Camera: Phoenix ICON (100° FOV); wide-field fundus photograph from neonatal ROP screening
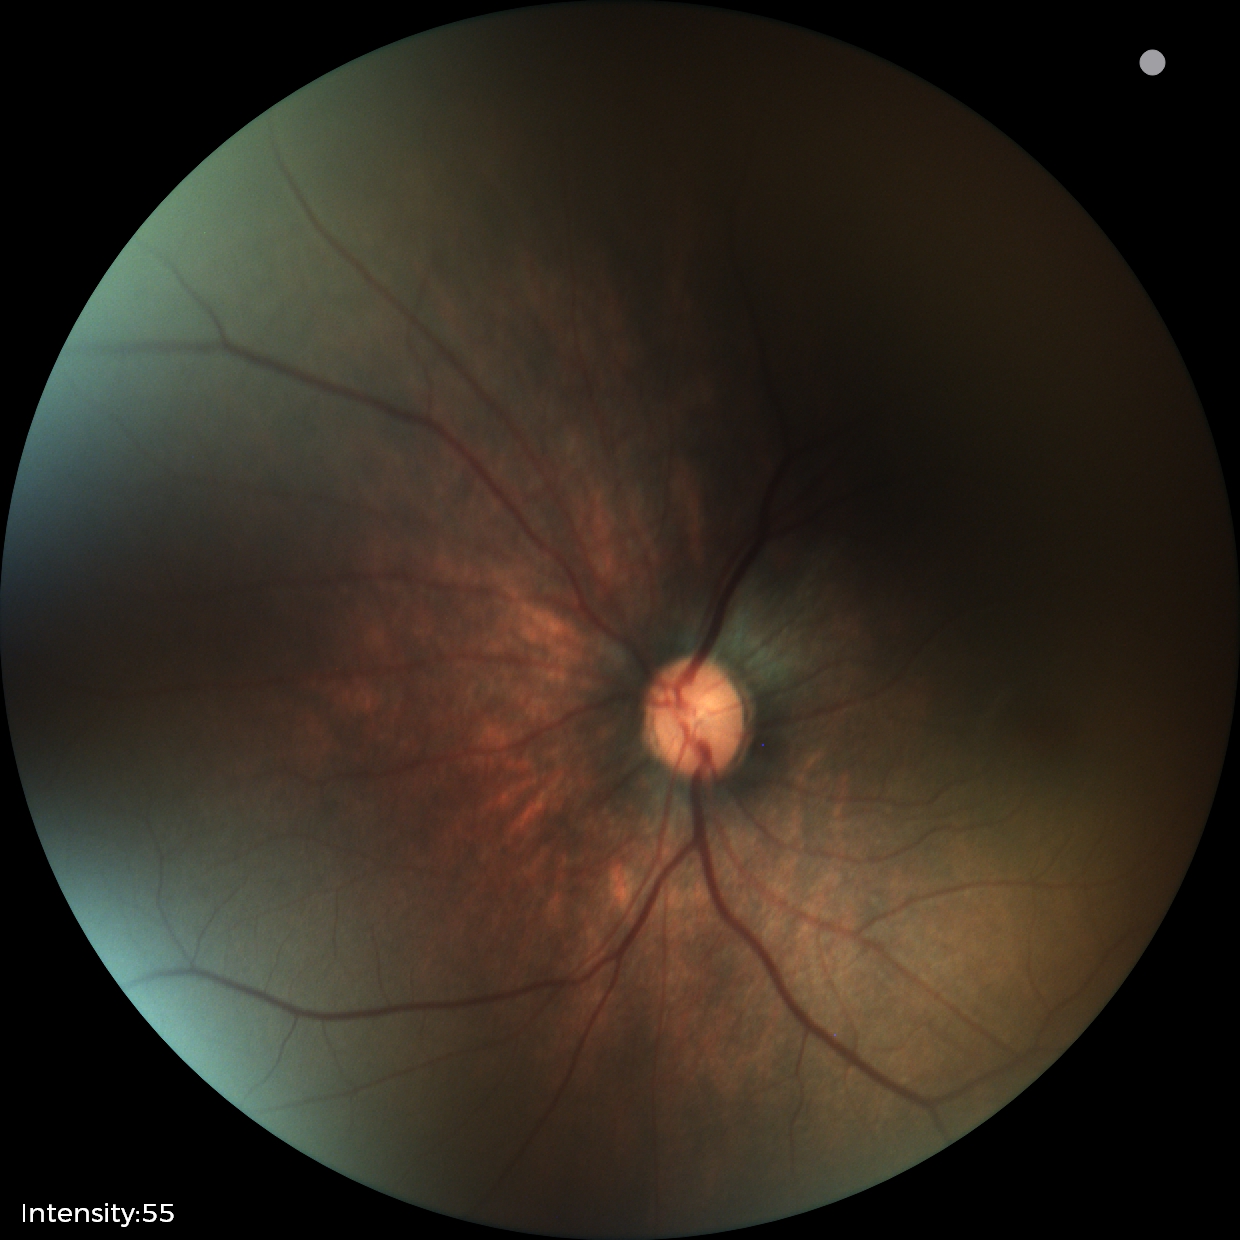 Examination with physiological retinal findings.